1240x1240 · wide-field contact fundus photograph of an infant — 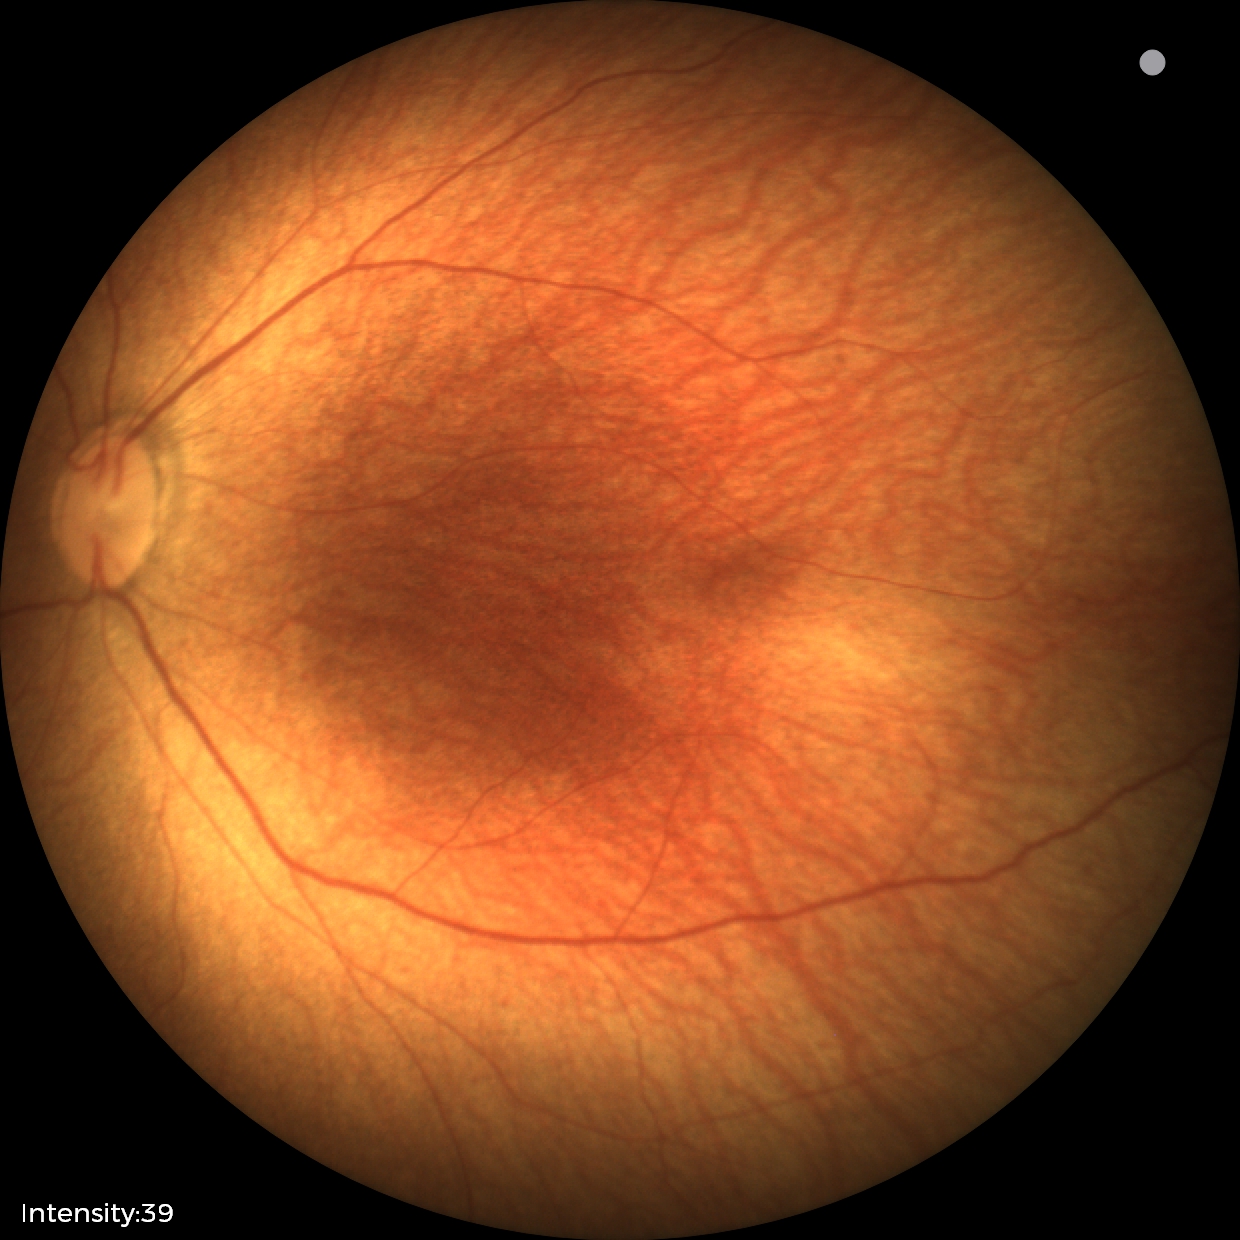

Impression: normal retinal appearance.